FOV: 45 degrees · 2048x1536:
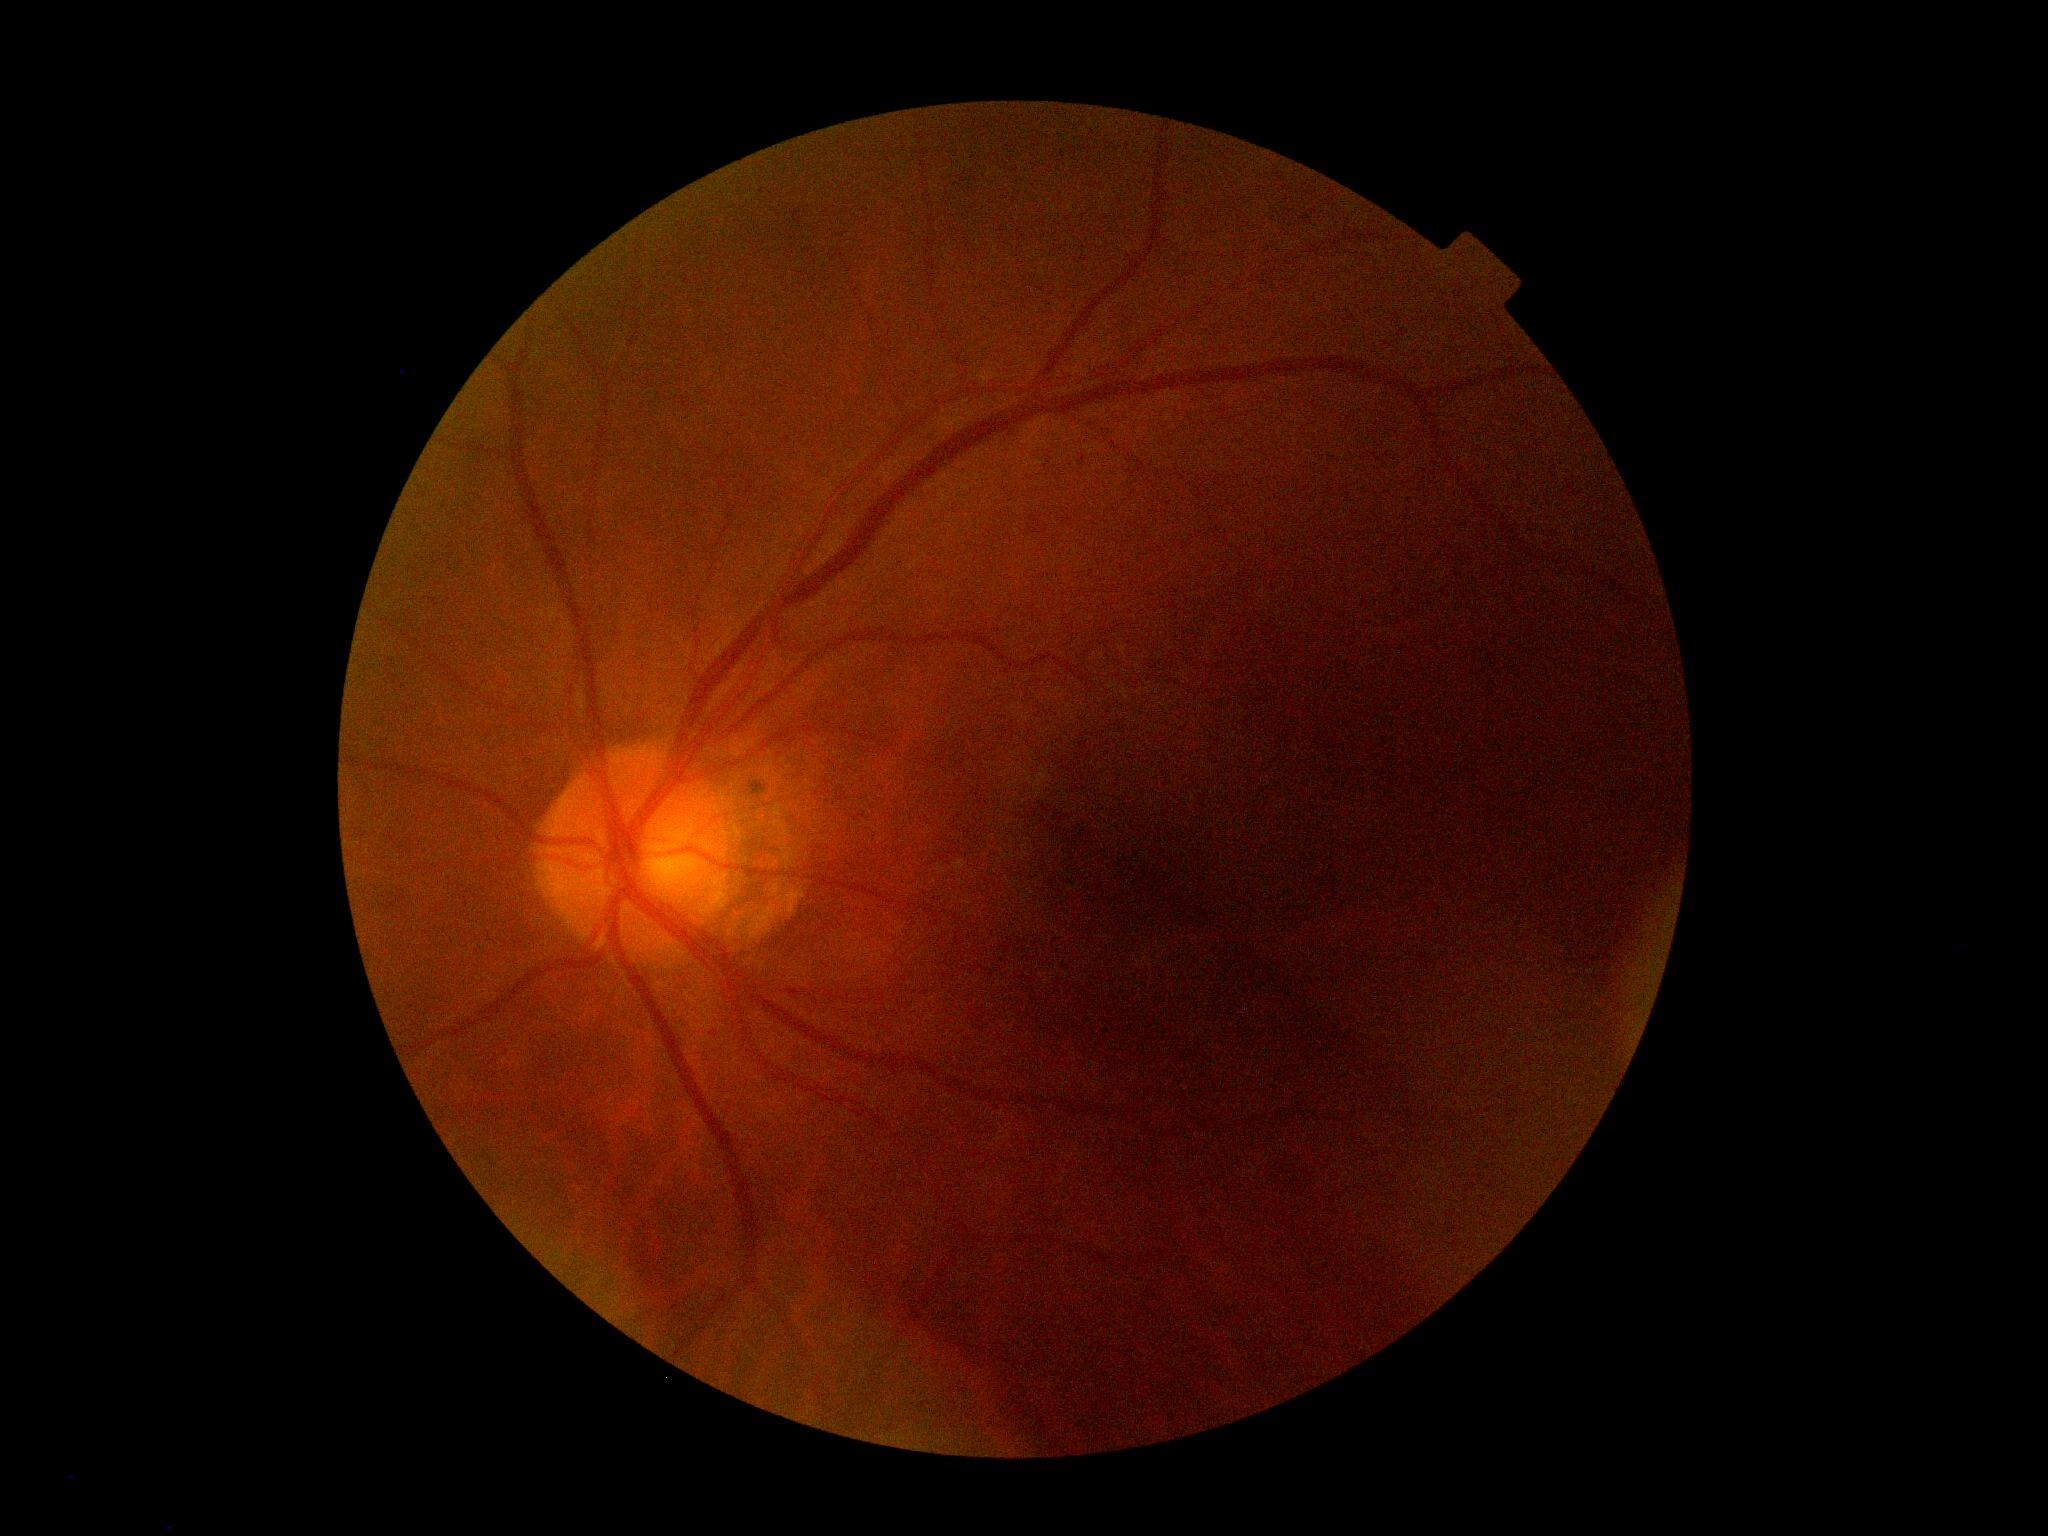 DR impression@no signs of DR; DR stage@0/4.